1440 x 1080 pixels. Wide-field fundus image from infant ROP screening. Acquired on the Natus RetCam Envision — 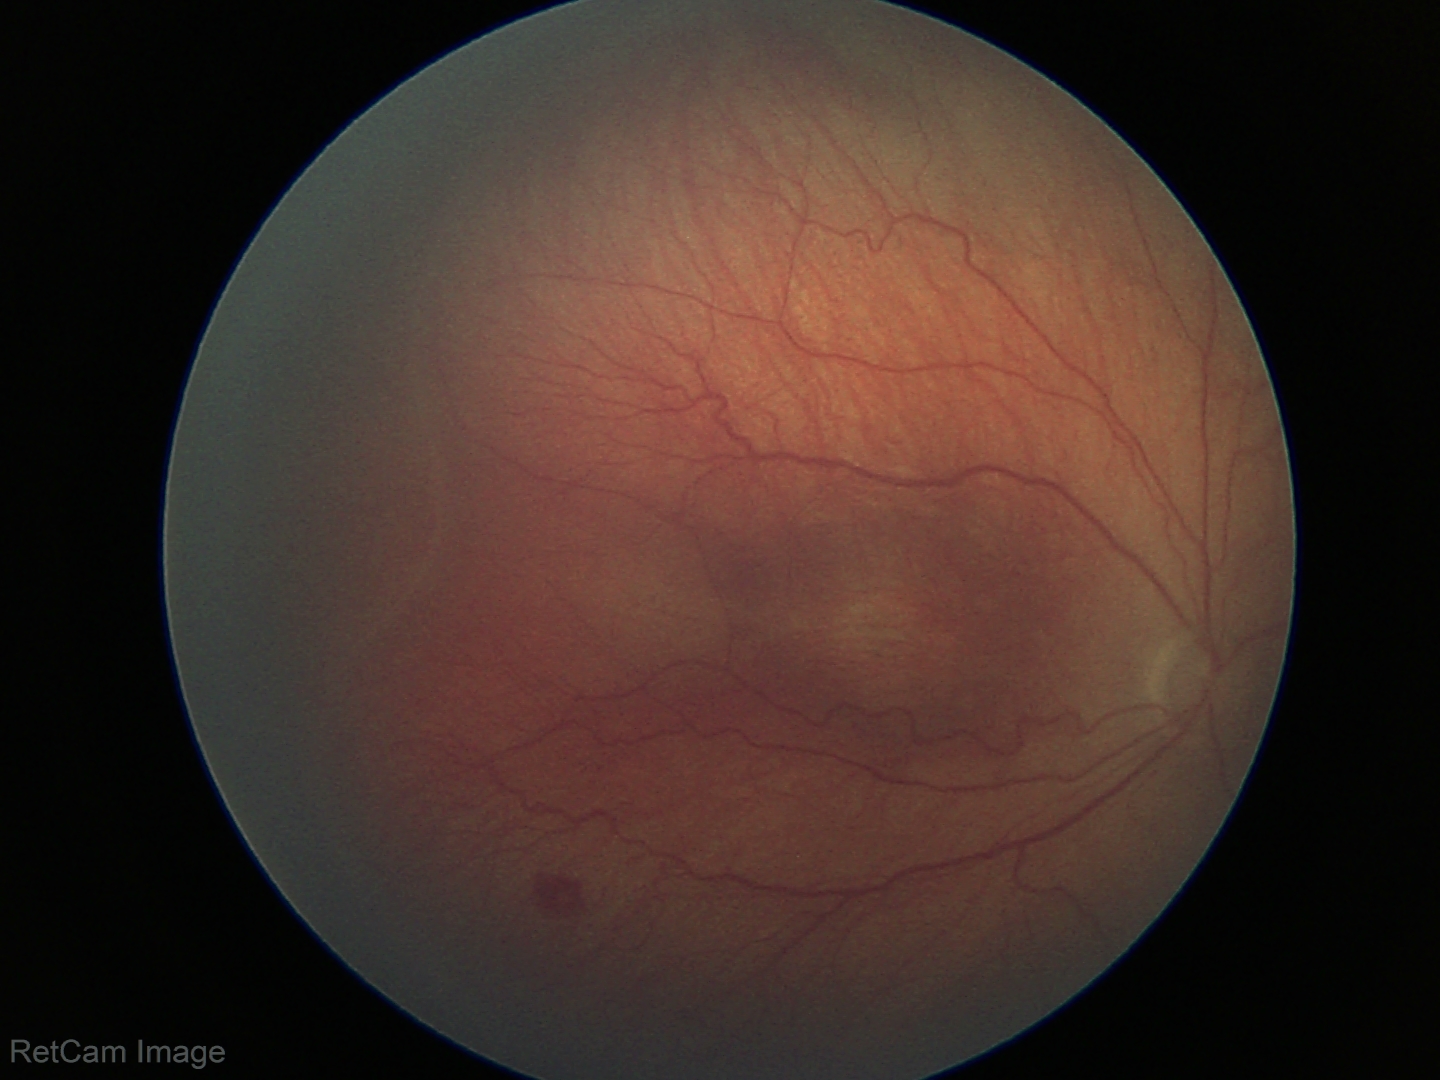

Plus disease absent. Diagnosis from this screening exam: ROP stage 3.